2048x1536px · 45° FOV · CFP:
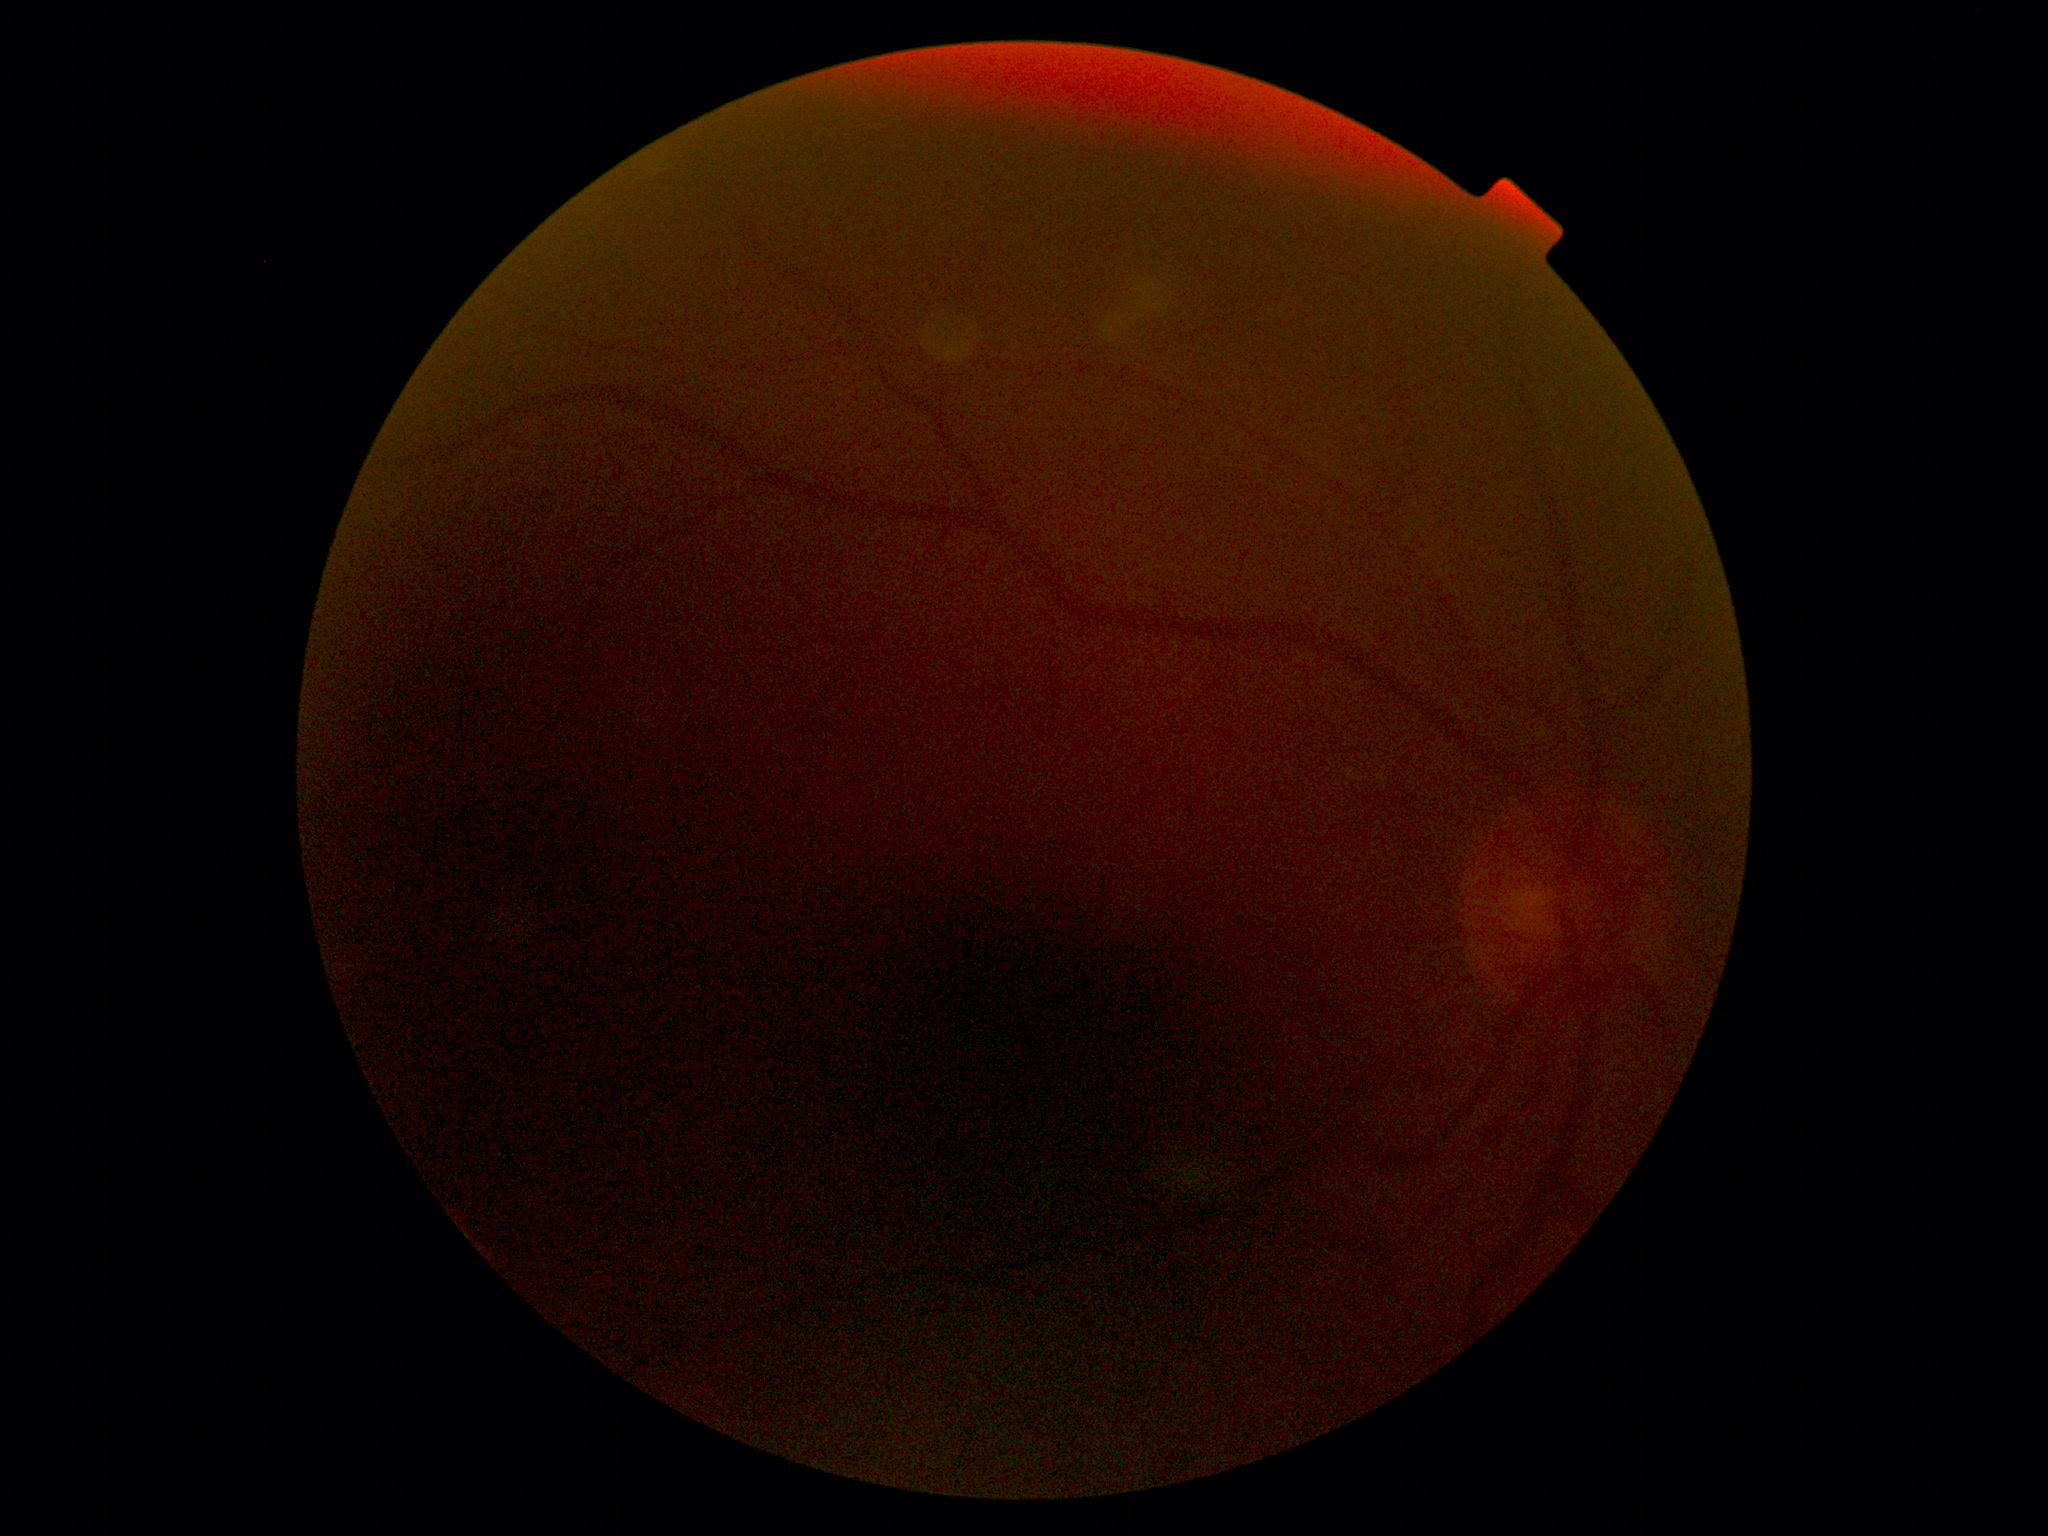 DR severity is ungradable.
Quality too poor to assess for DR.